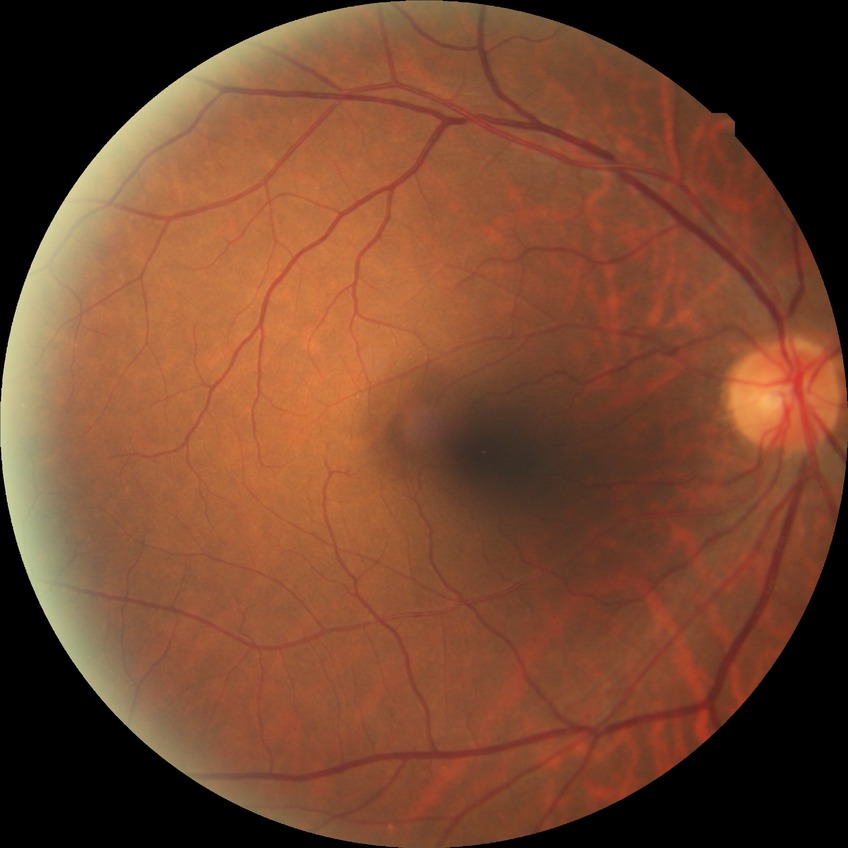 Diabetic retinopathy severity is no diabetic retinopathy.